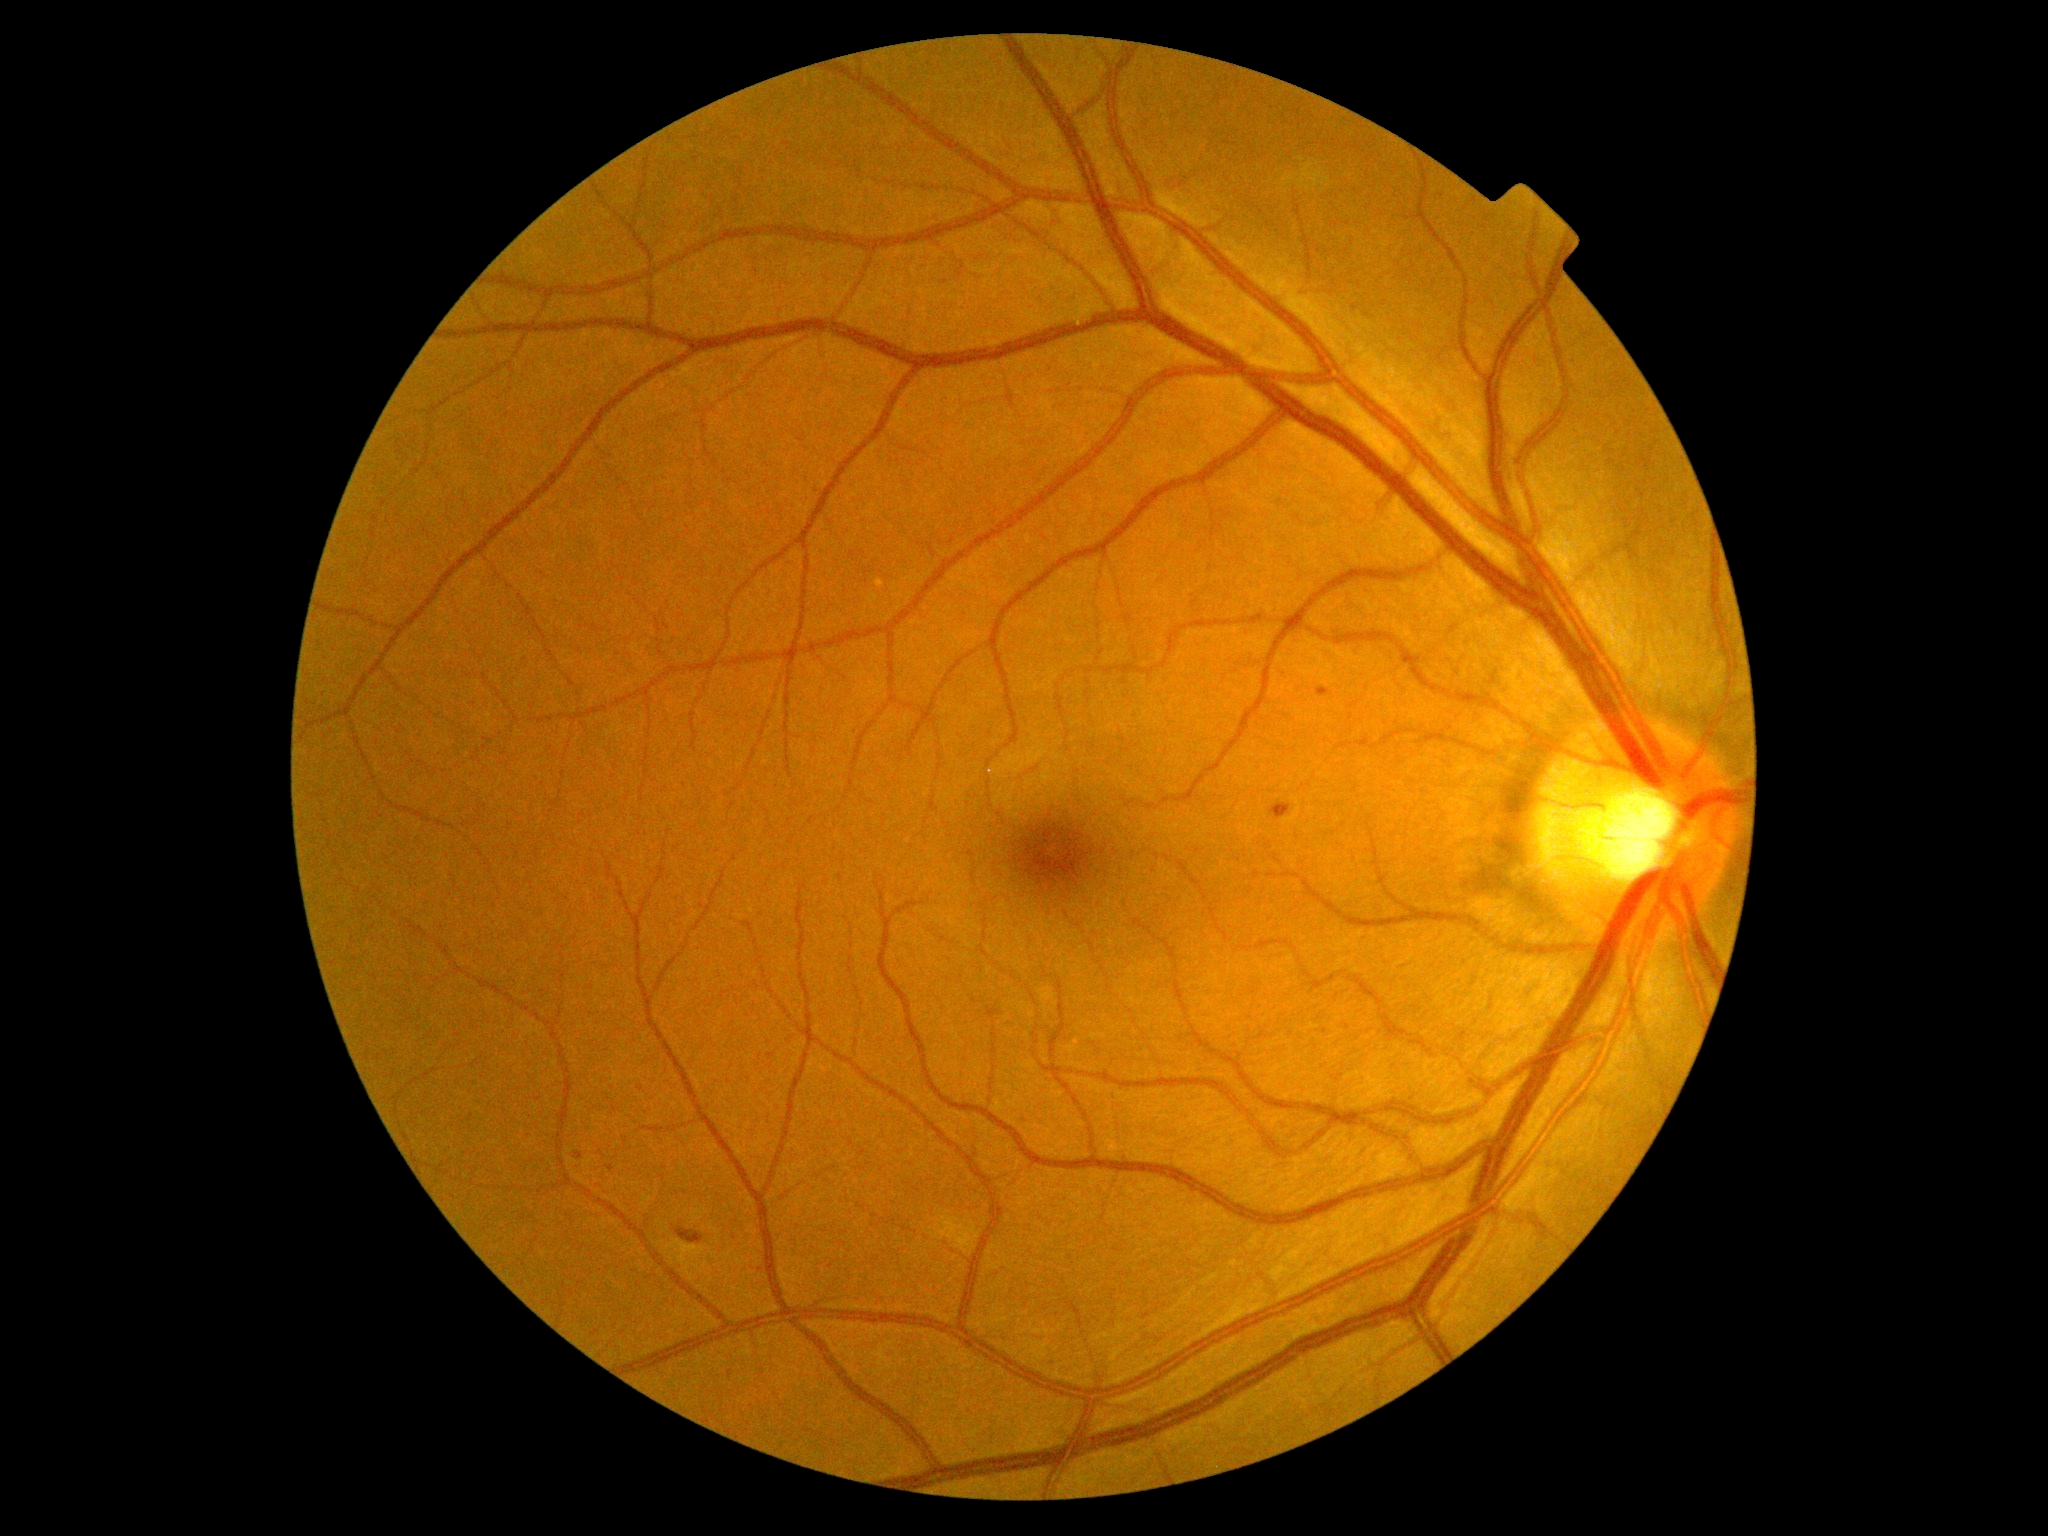 DR is moderate NPDR (grade 2)
HEs: BBox(1271, 803, 1292, 821) | BBox(677, 1229, 704, 1245)
MAs: BBox(1317, 687, 1330, 697) | BBox(575, 1153, 584, 1160)
SEs: none detected
EXs: none detected